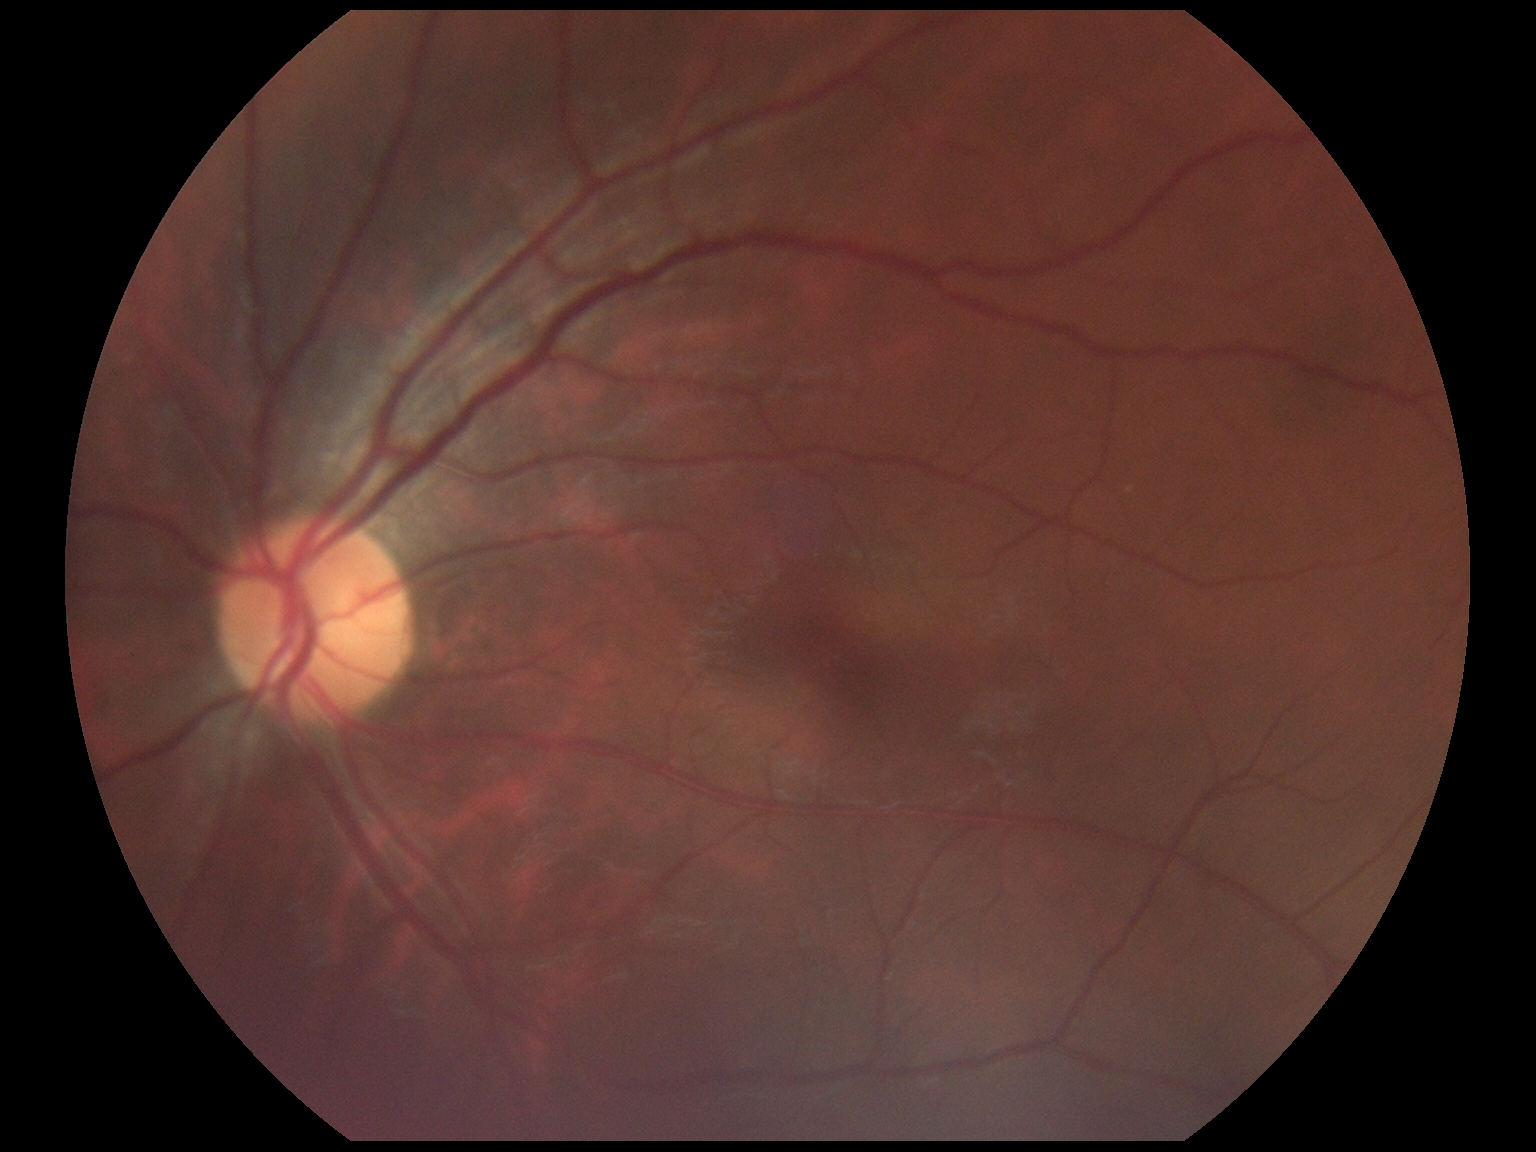

Retinopathy: grade 0 (no apparent retinopathy).